Retinal fundus photograph: 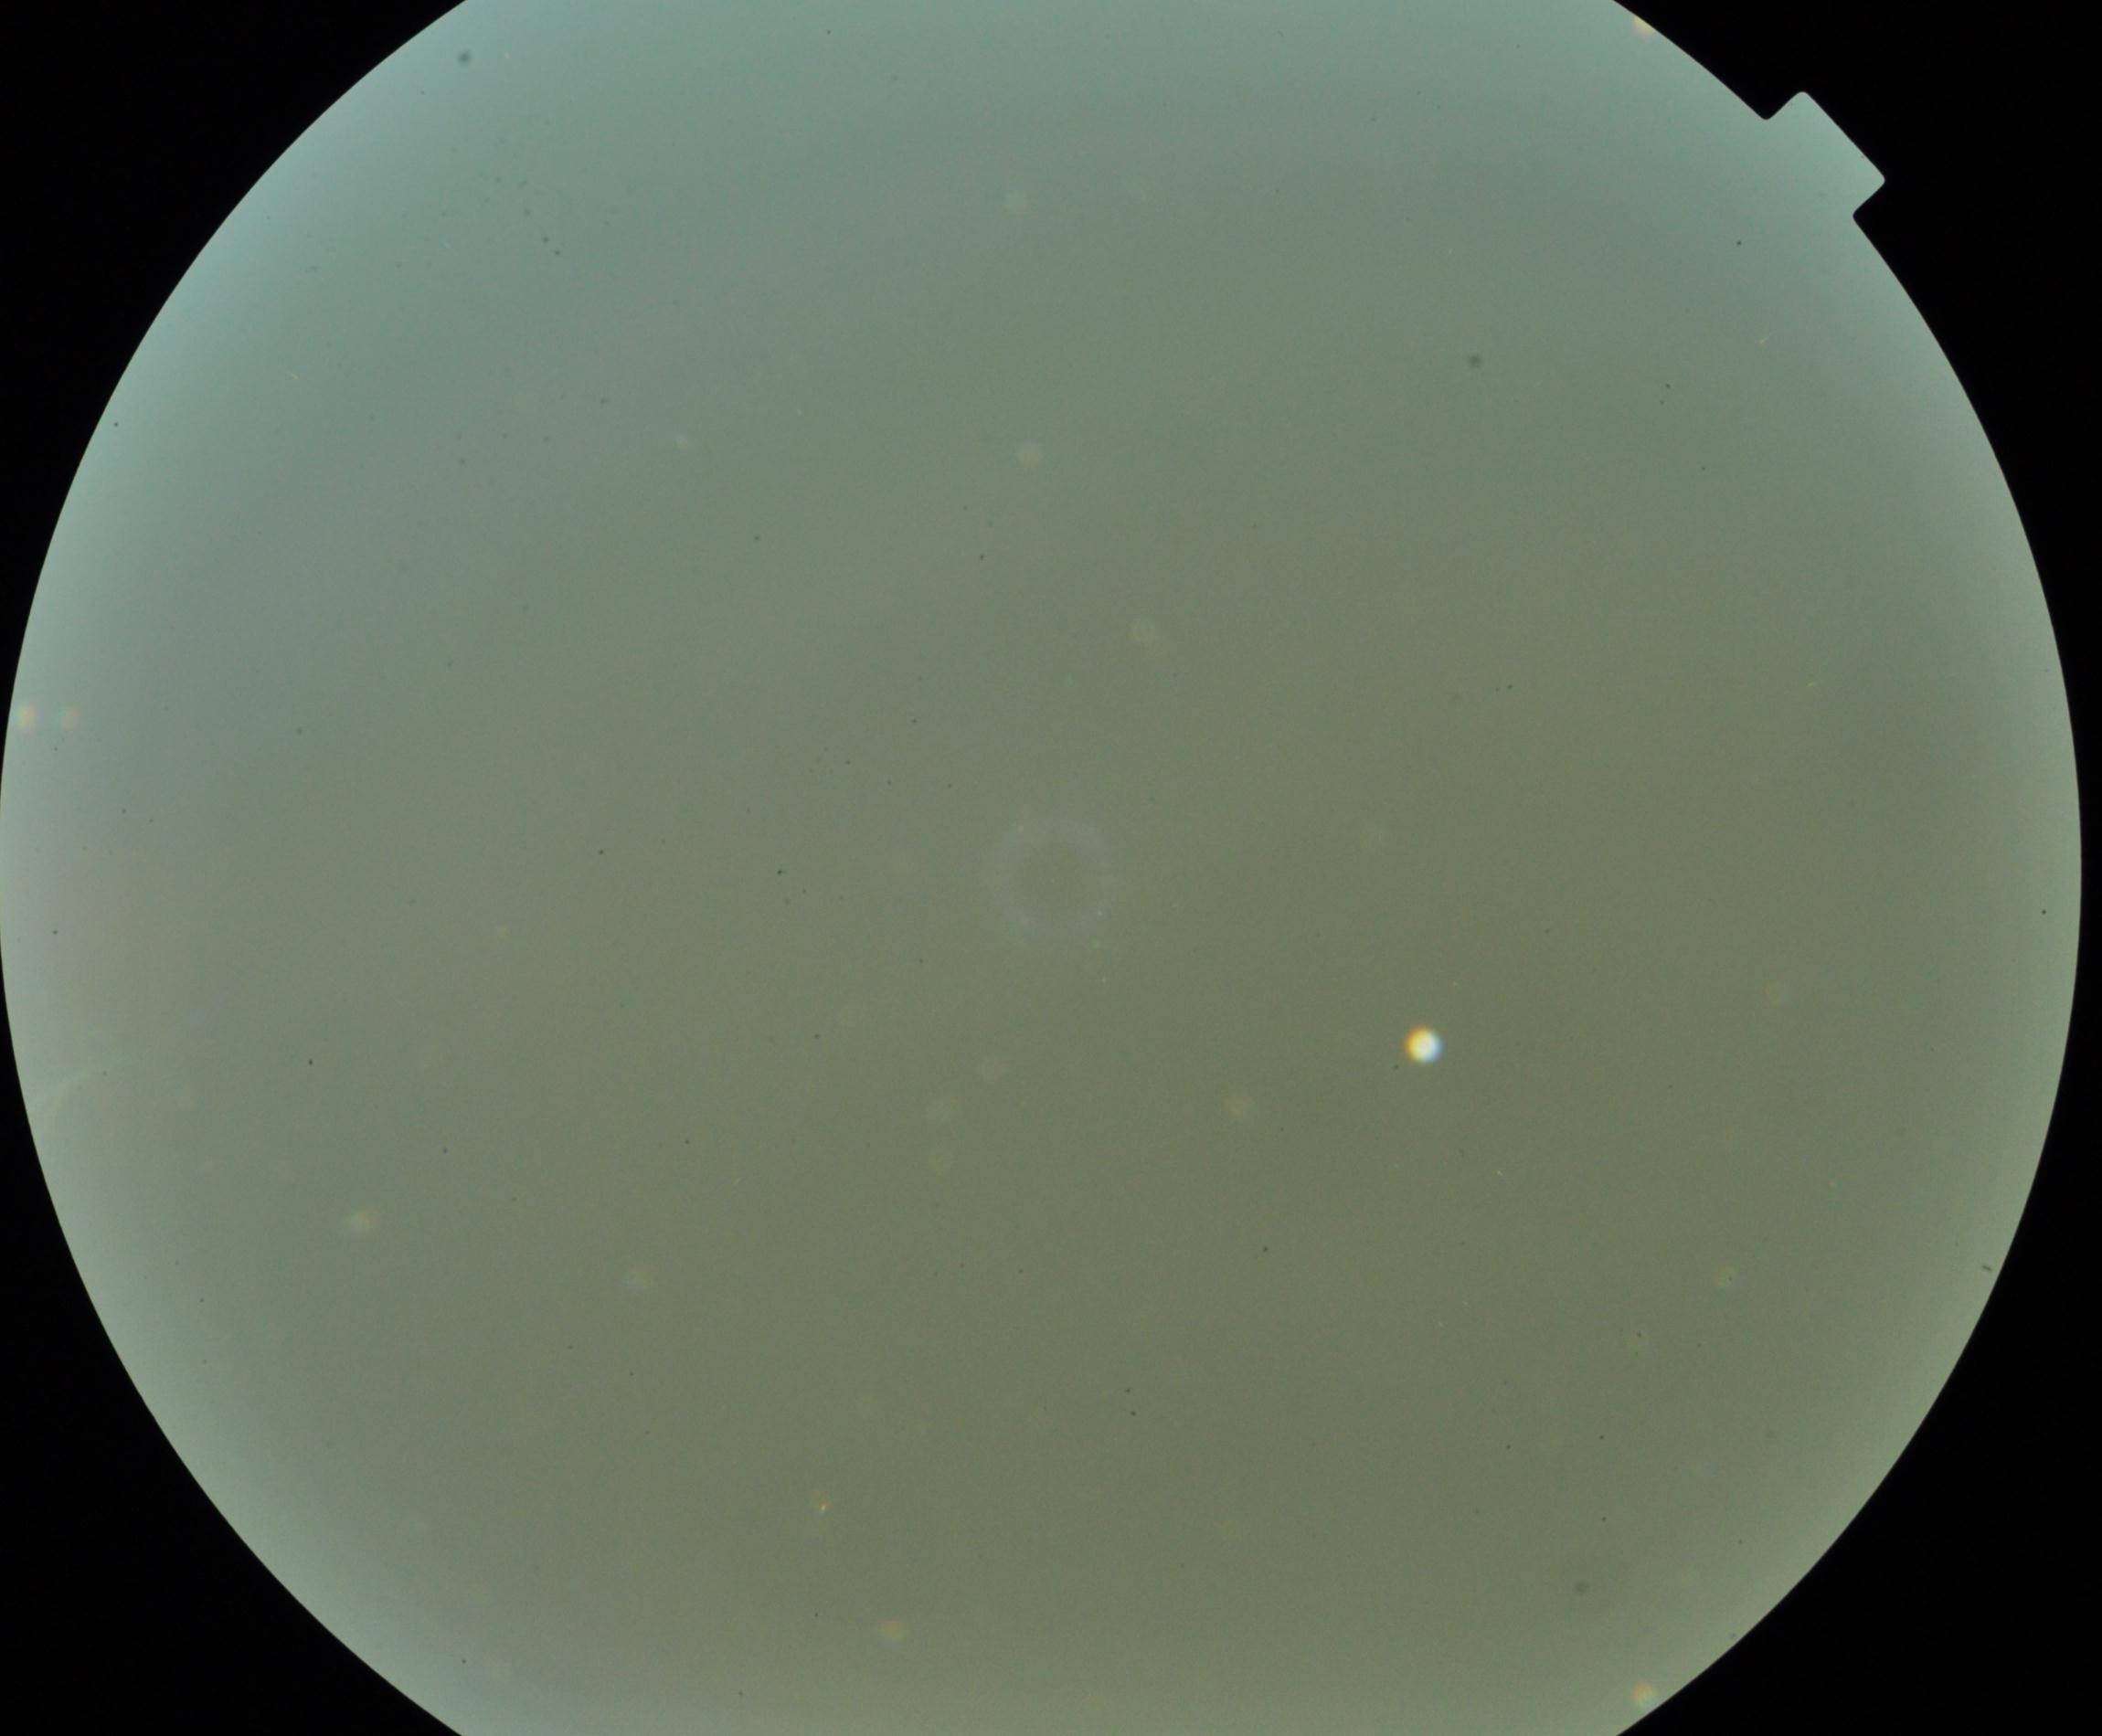 Image quality is poor; more than half the field is obscured. No evidence of proliferative diabetic retinopathy.